Central corneal thickness: 564 µm · 64 years old · axial length 22.66 mm · refraction: +2.75 -2.25 × 83° · sex: female · intraocular pressure (IOP): 19 mmHg: 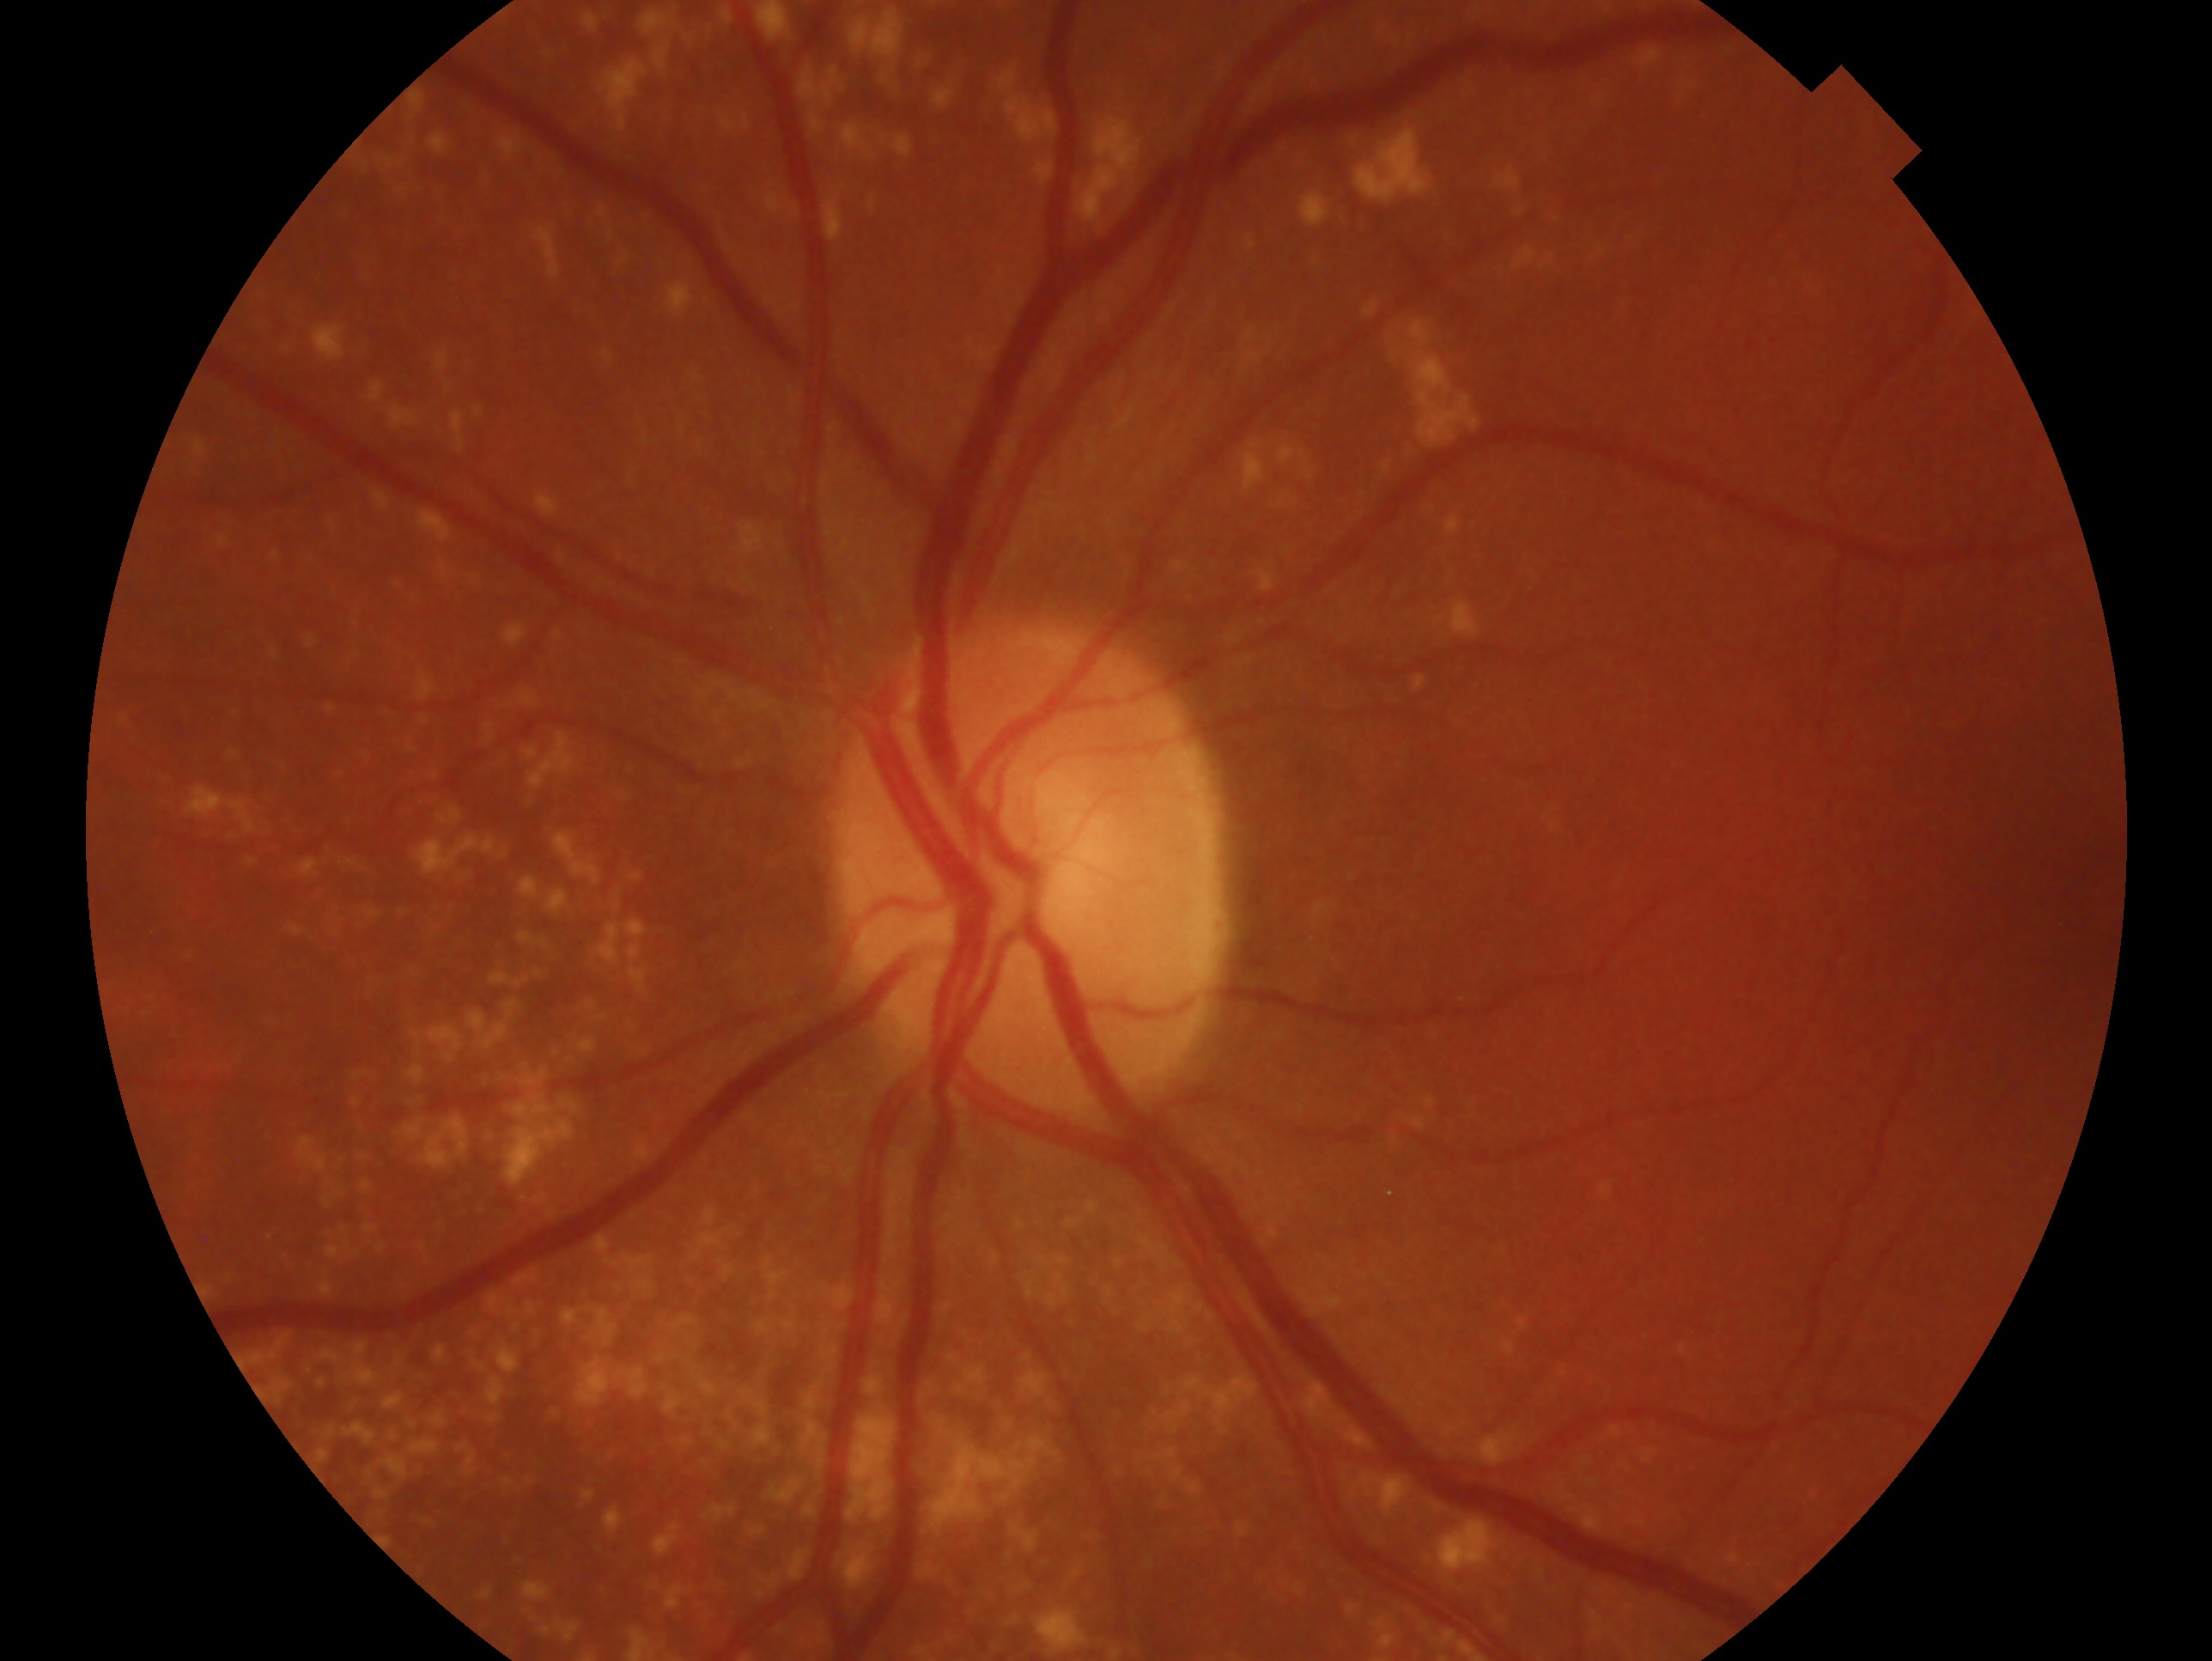
Glaucoma diagnosis — no evidence of glaucoma.
Eye: OS.